Wide-field fundus photograph from neonatal ROP screening; Clarity RetCam 3, 130° FOV:
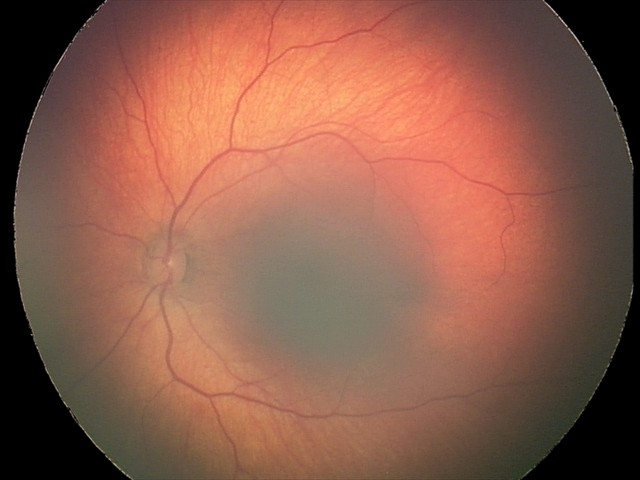
Assessment: retinal hemorrhages.